Mydriatic (tropicamide 0.5%); macula at the center of the field.
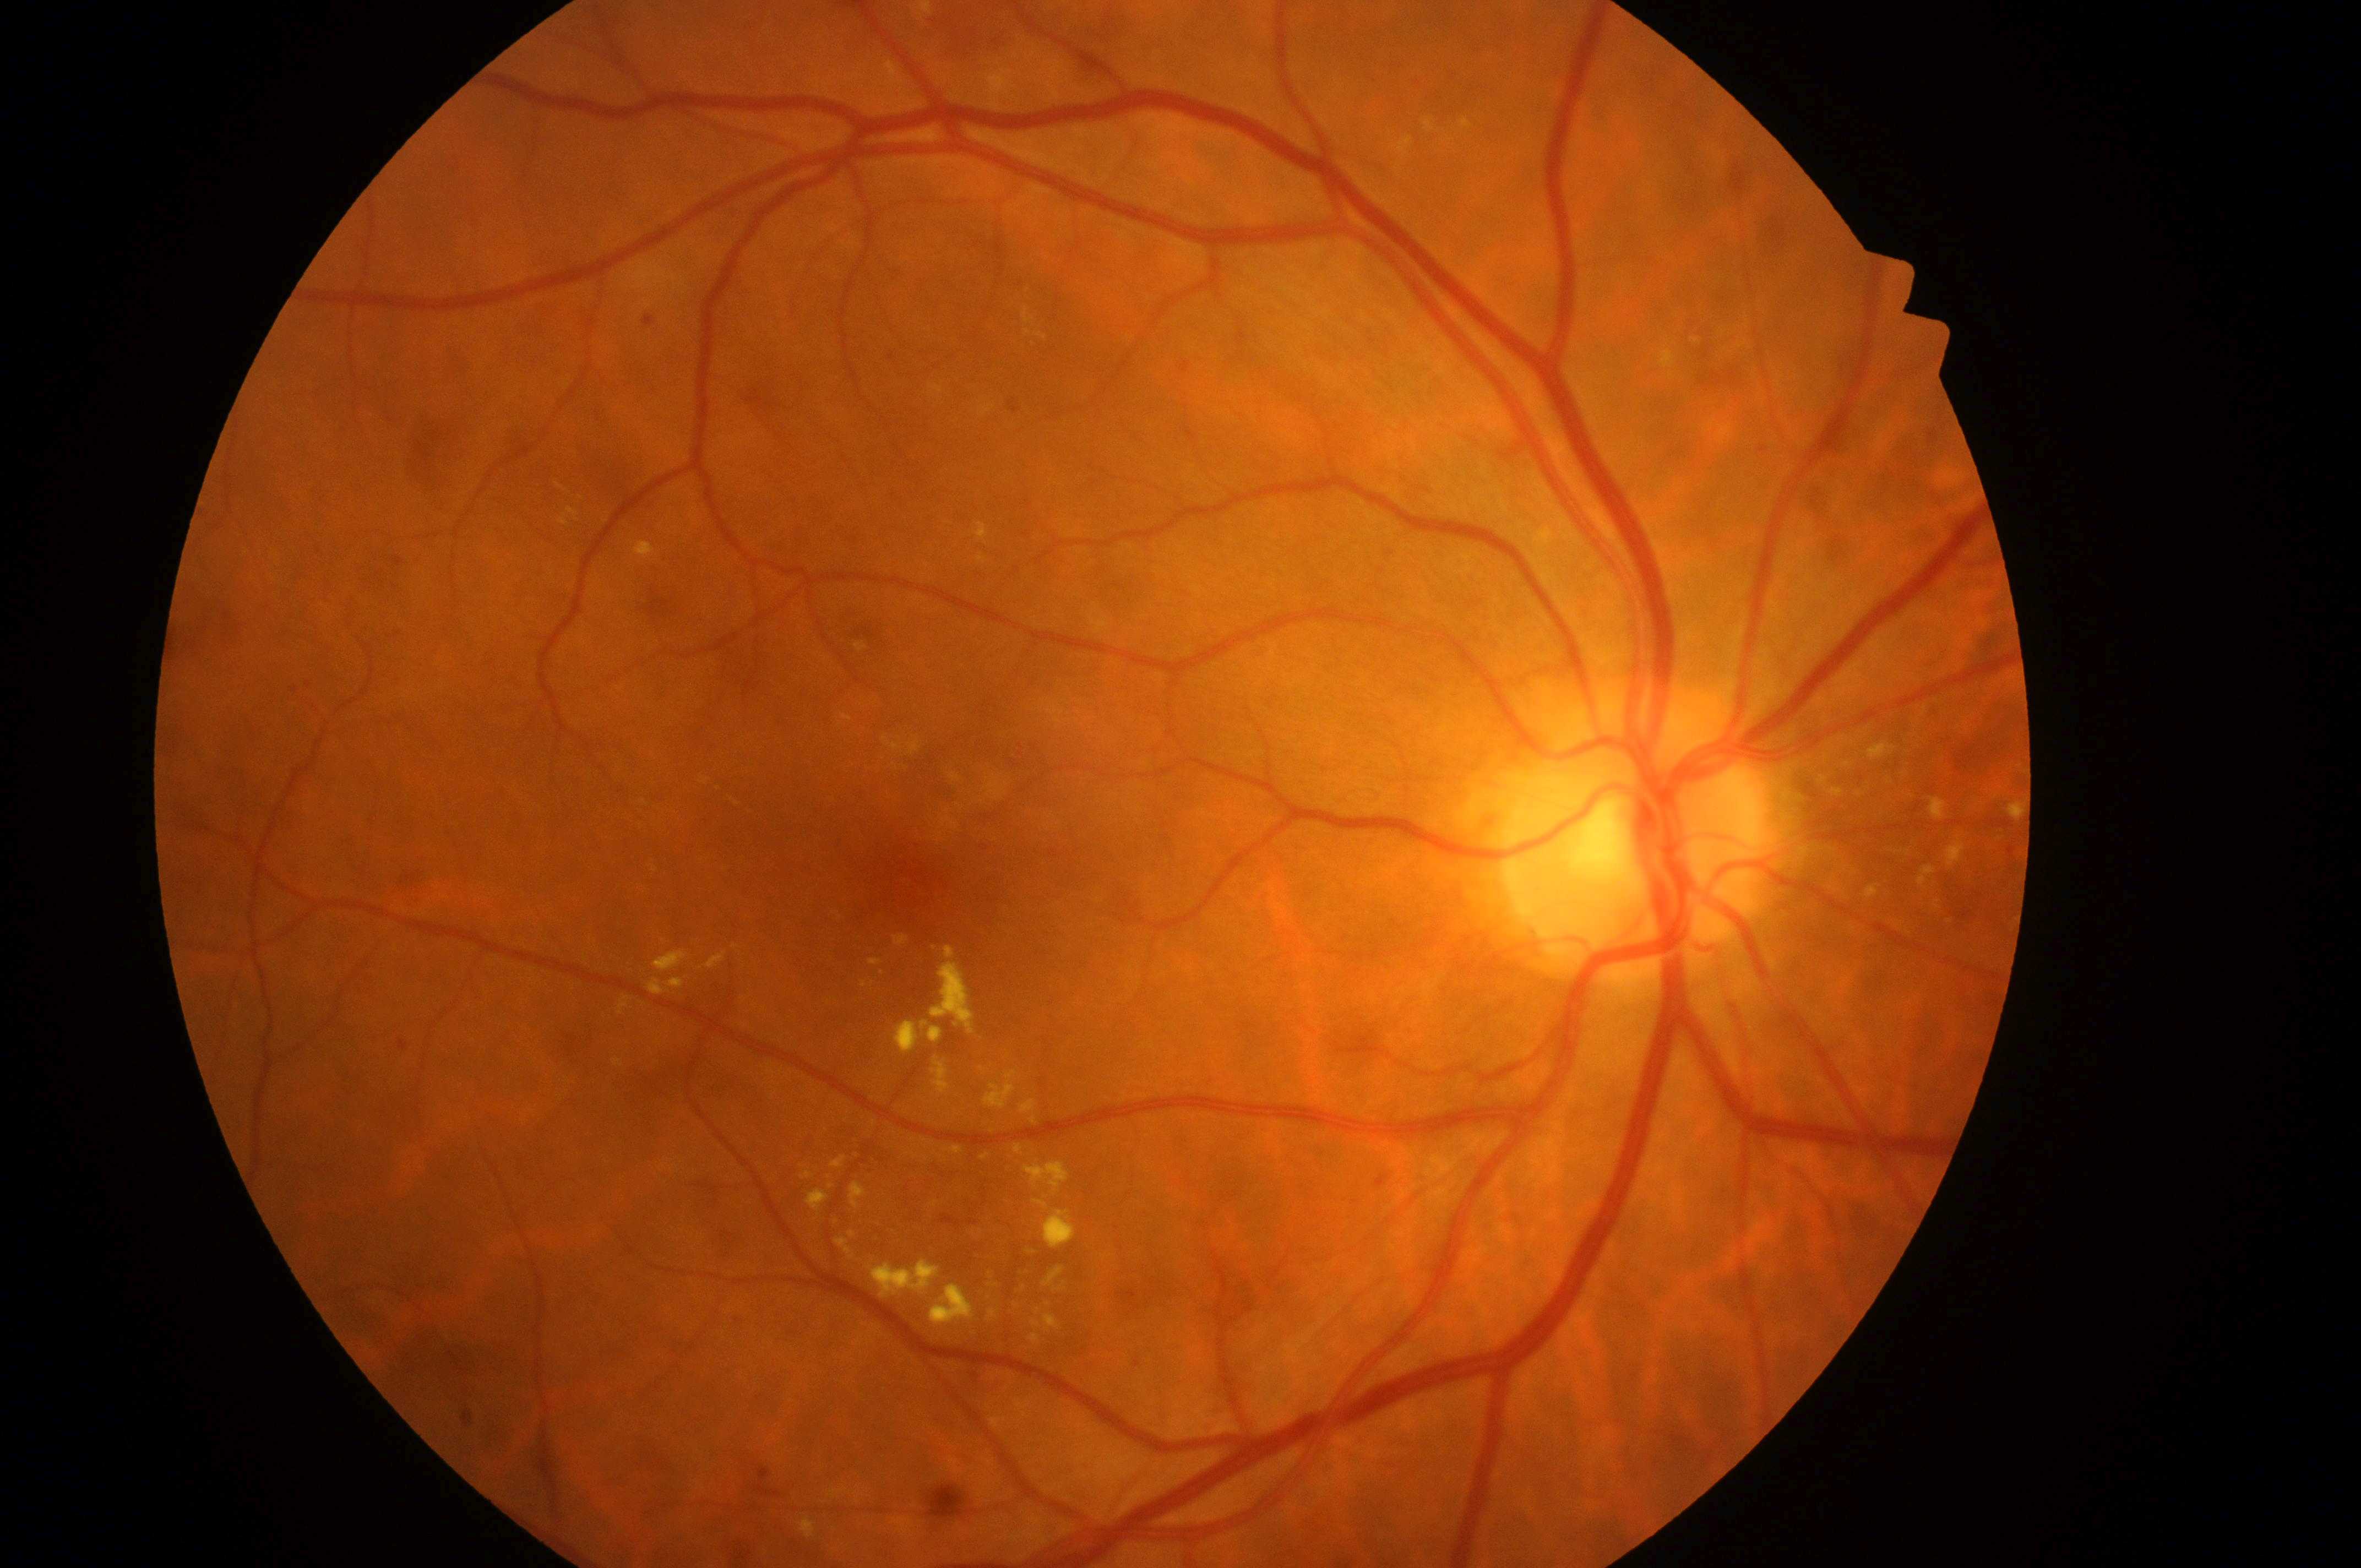 Eye: OD.
Optic disk: (1623,847).
DR stage is grade 2.
Macula center: (920,878).
DME grade: 2.